Color fundus image. 2089x1764px
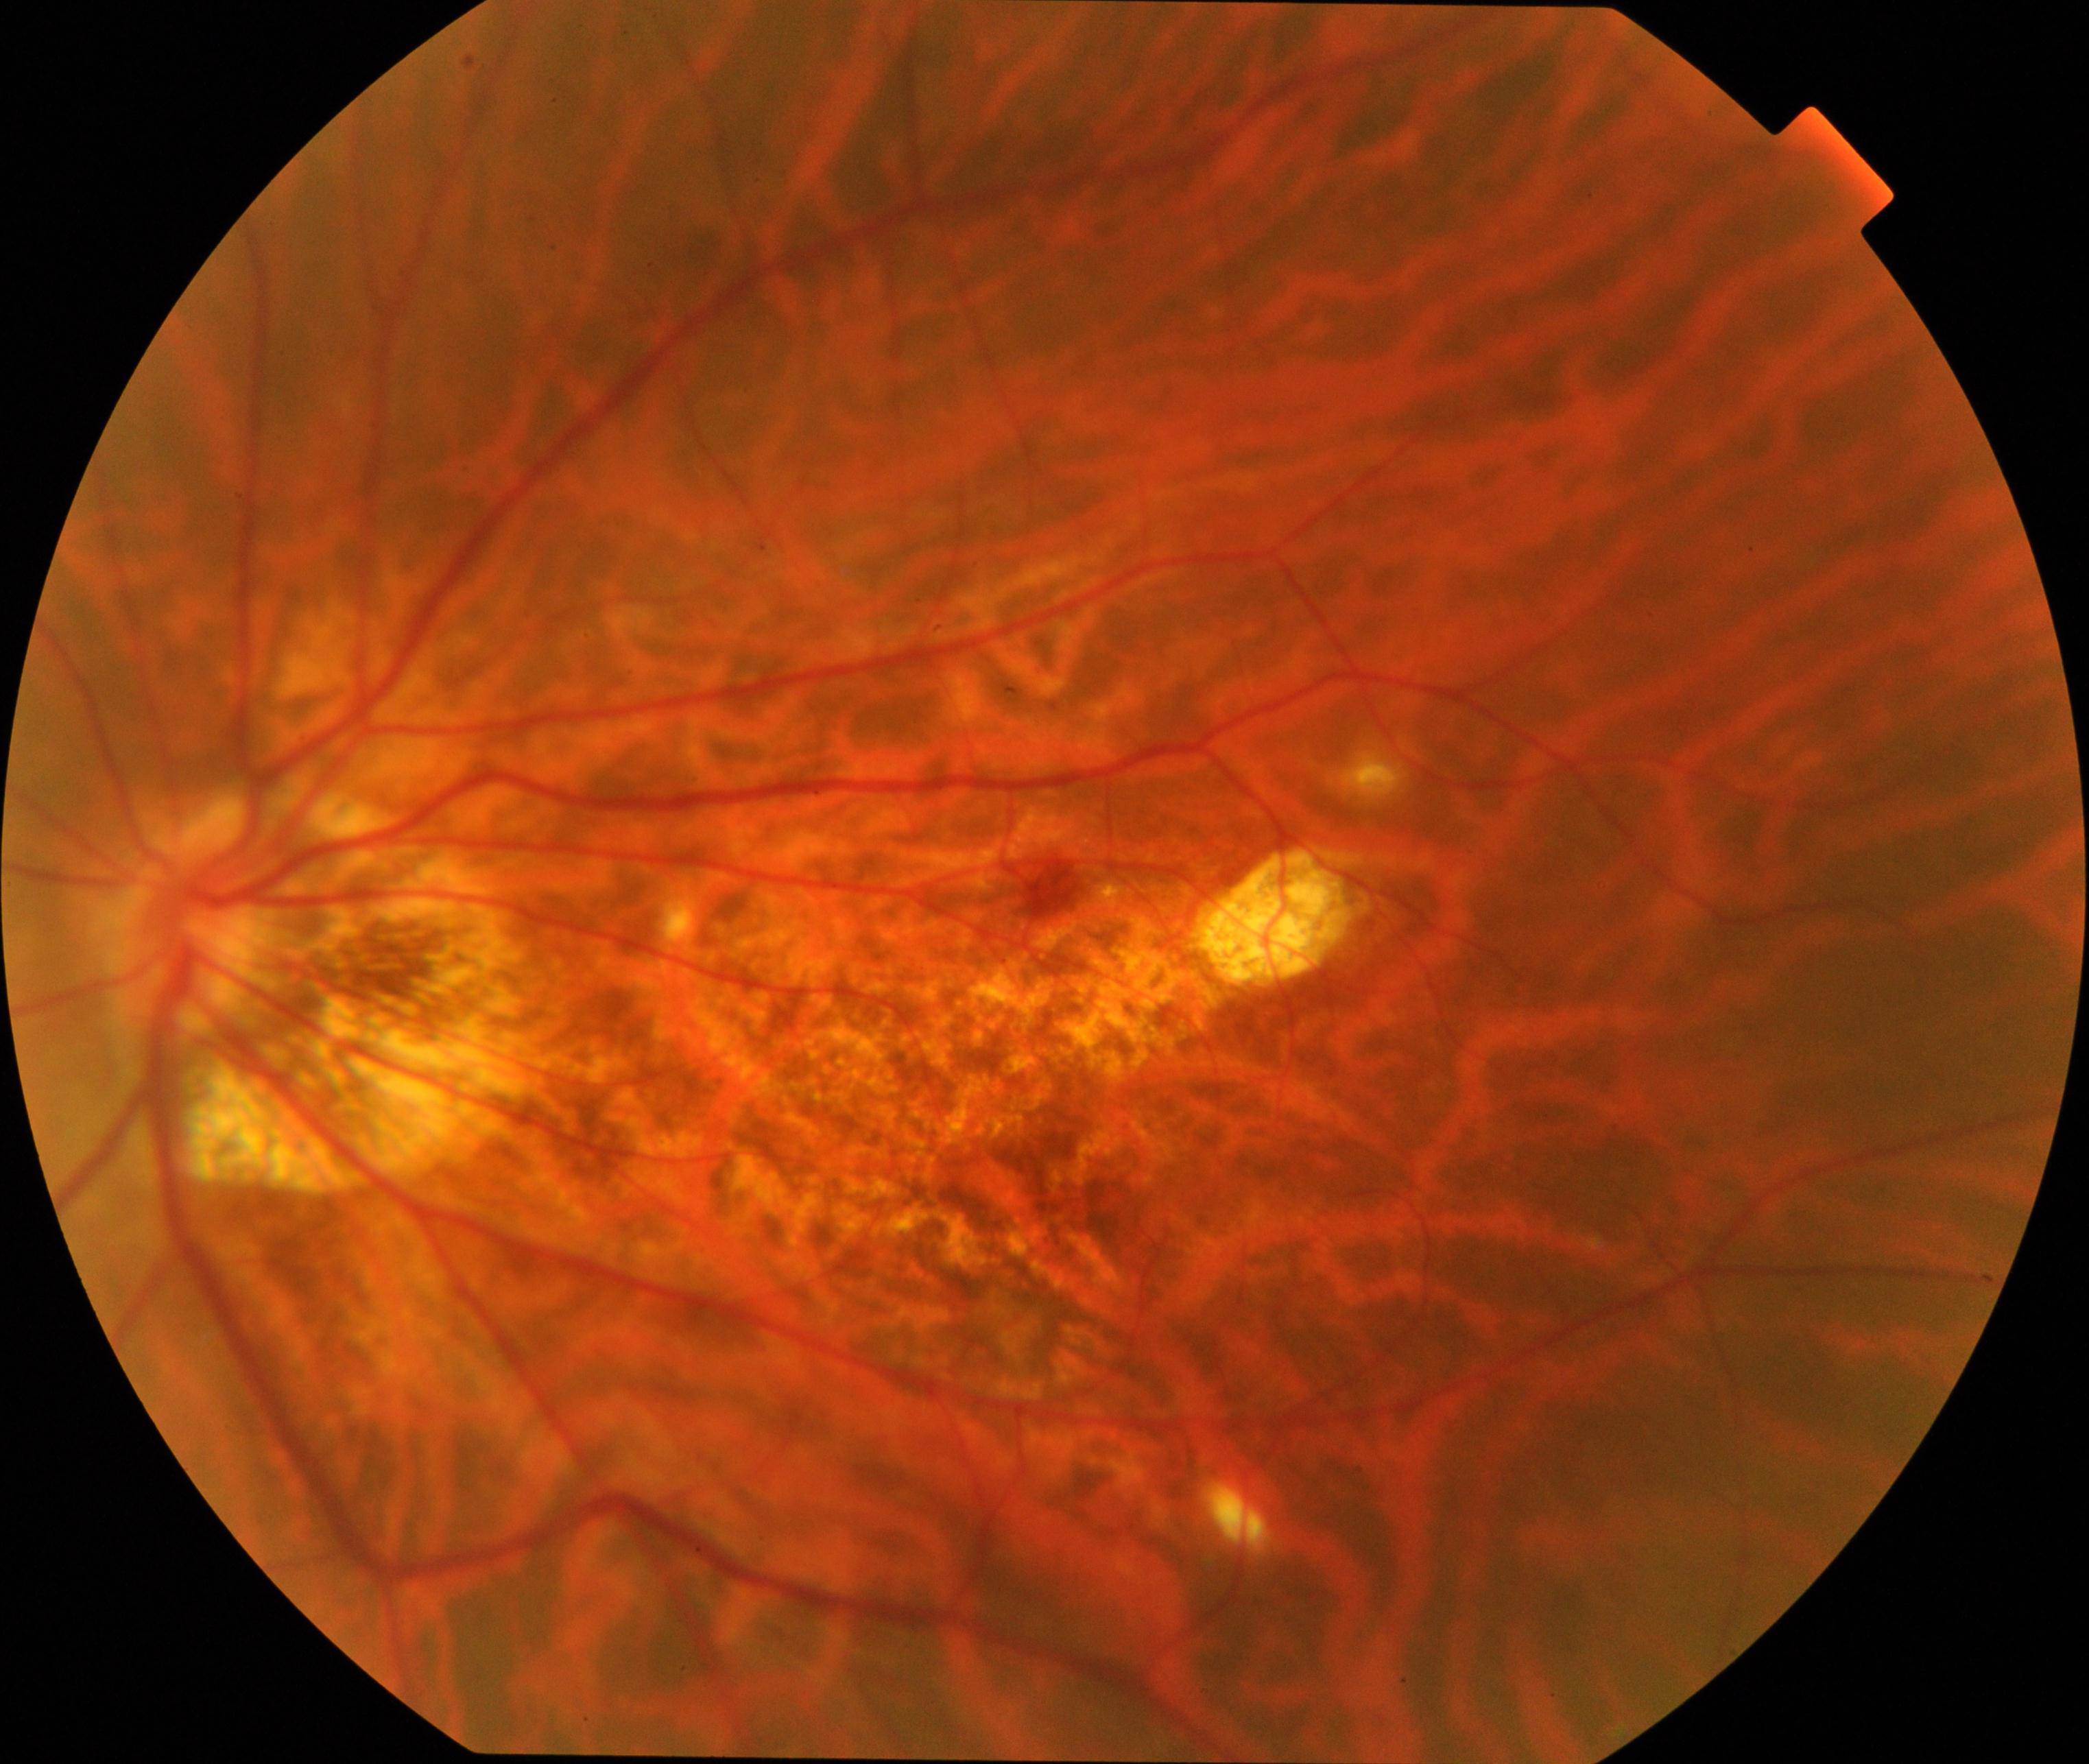
Diagnosis: pathological myopia.